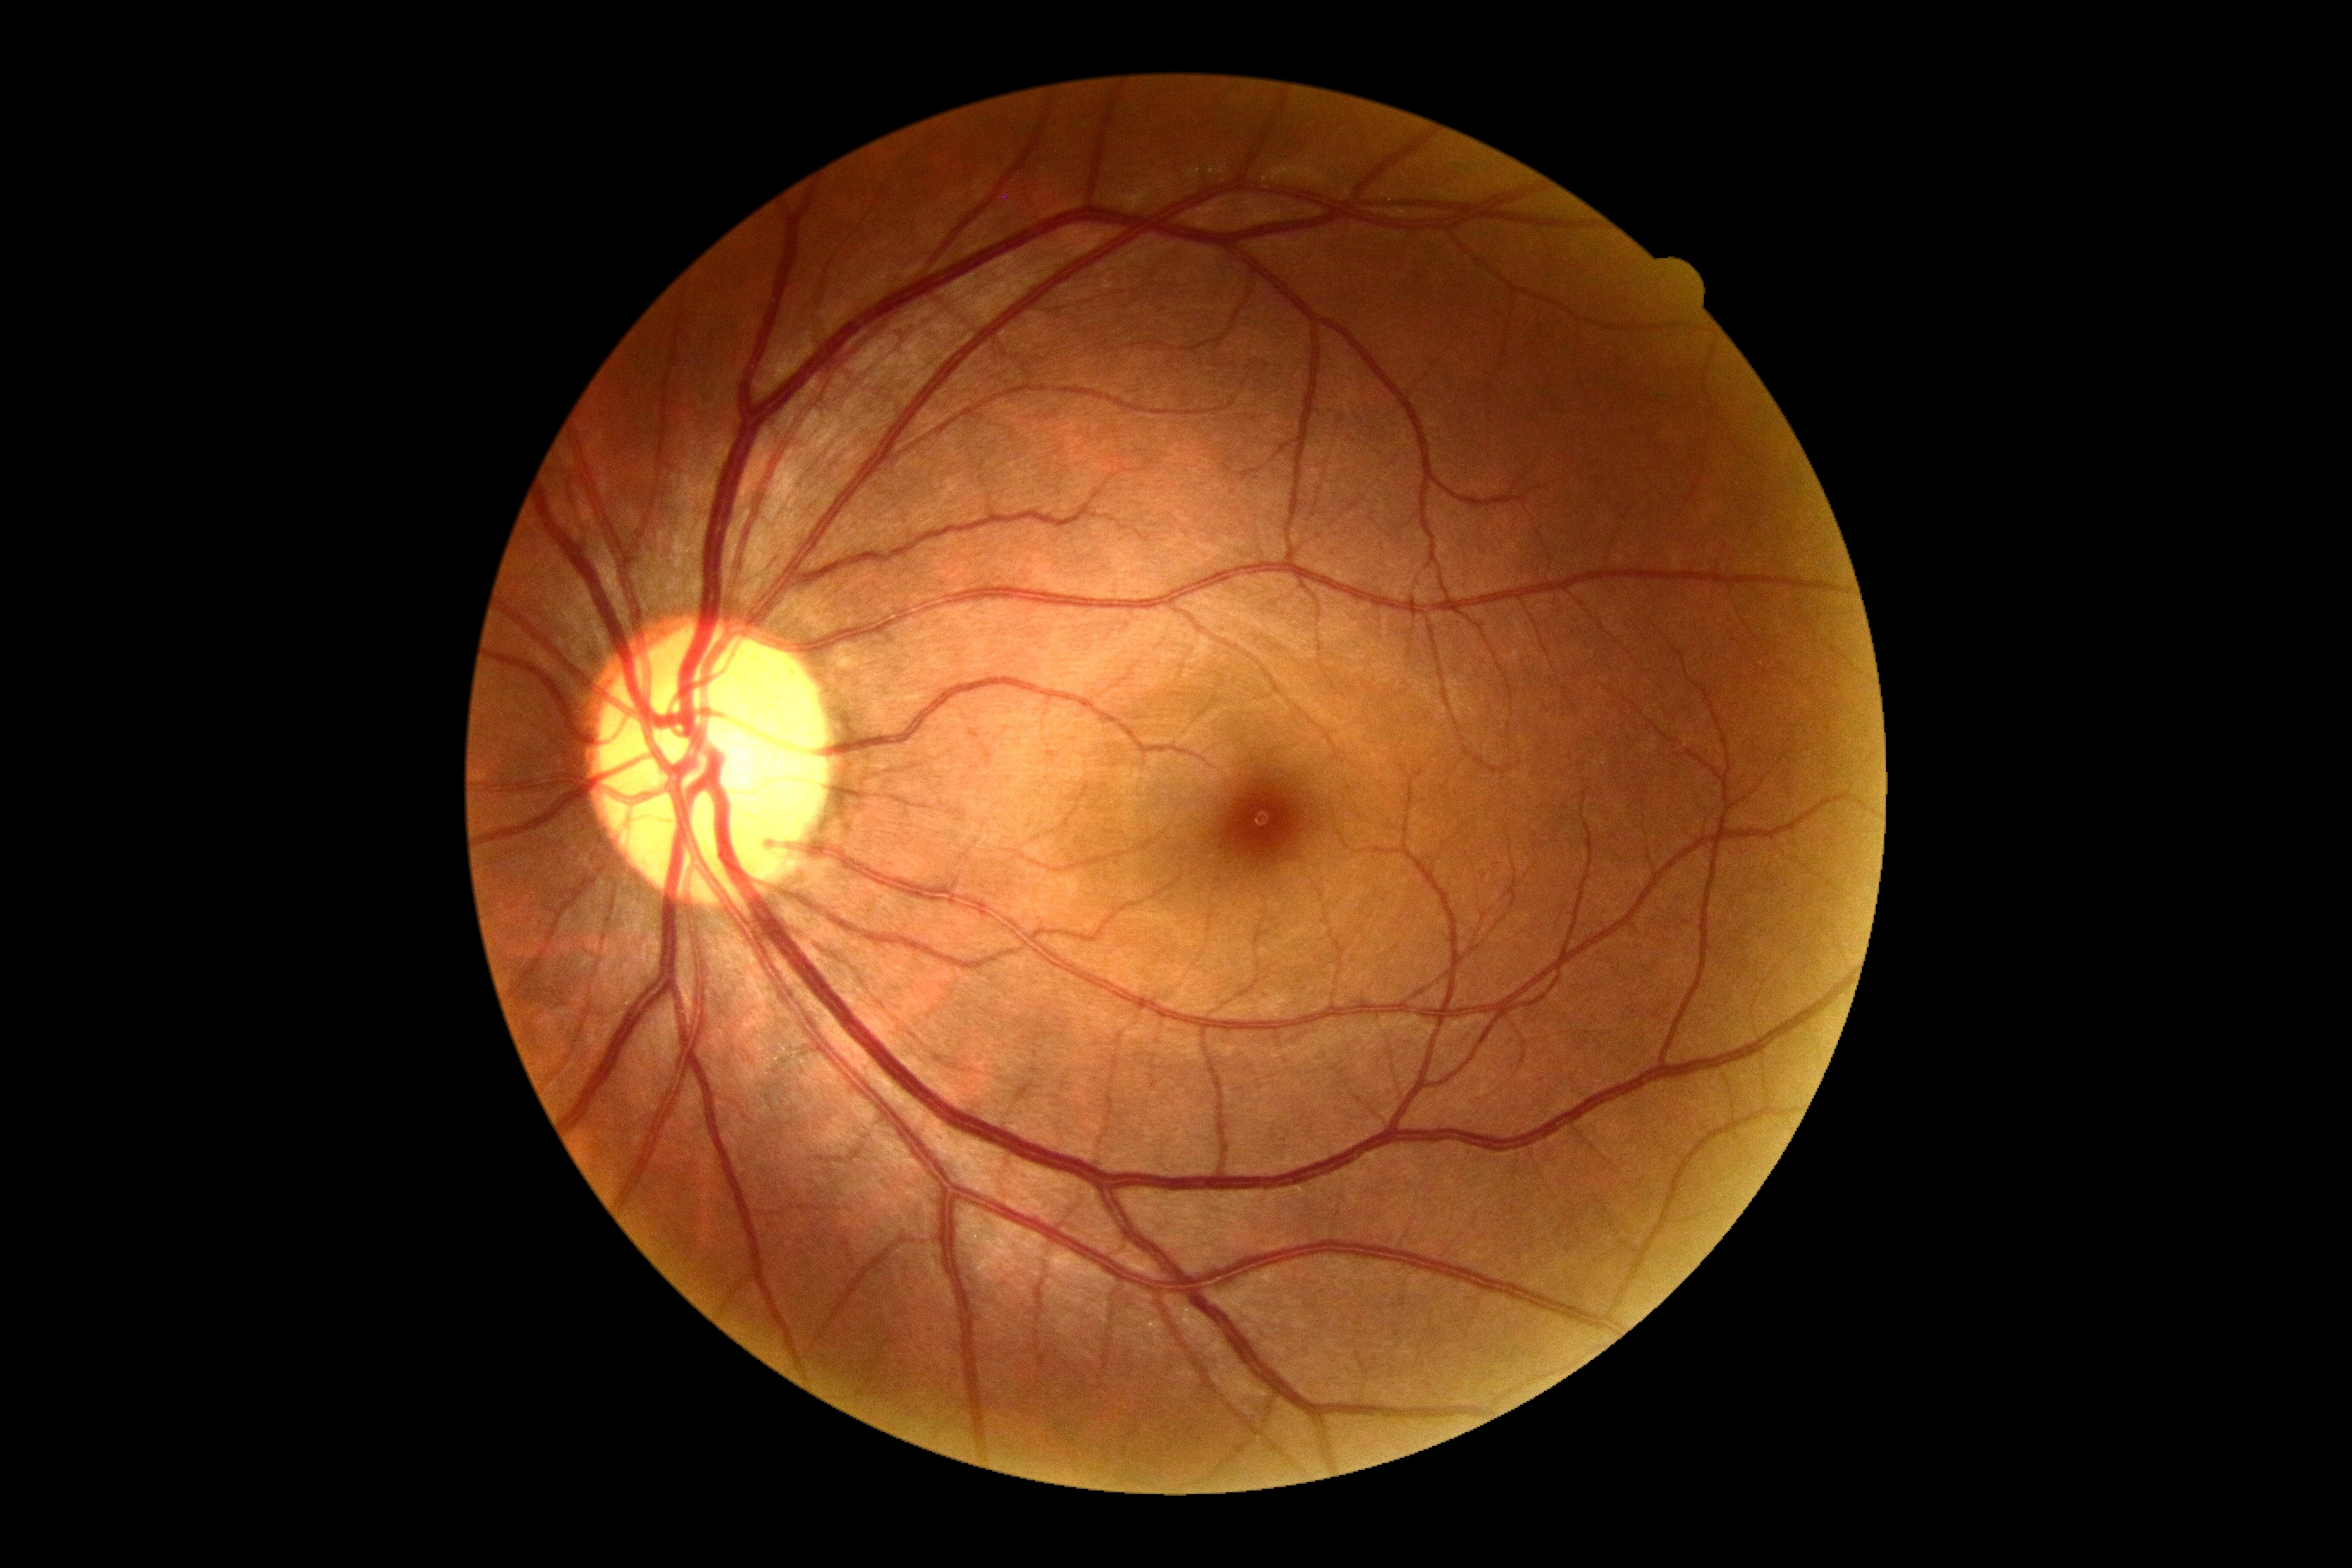
diabetic retinopathy (DR)@no apparent diabetic retinopathy (grade 0).